240 x 240 pixels, Nidek AFC-330, non-mydriatic acquisition — 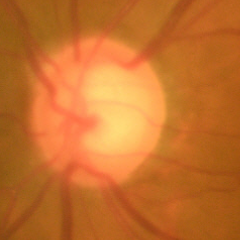

Glaucoma diagnosis: no signs of glaucoma.